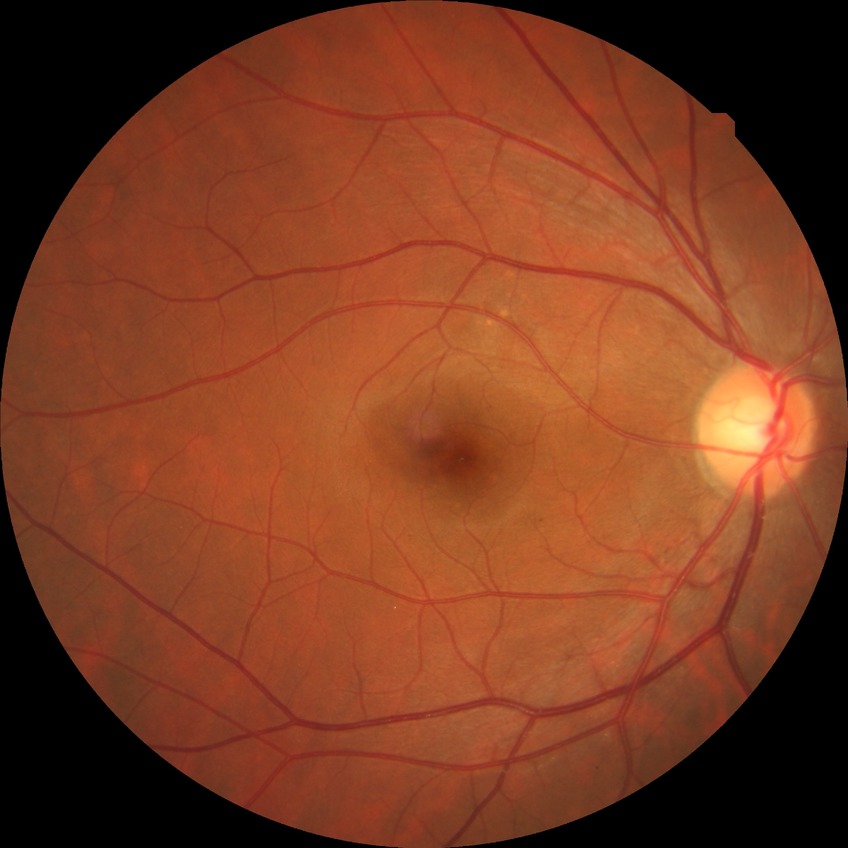 No signs of diabetic retinopathy. DR severity: NDR.